50° field of view. Retinal fundus photograph
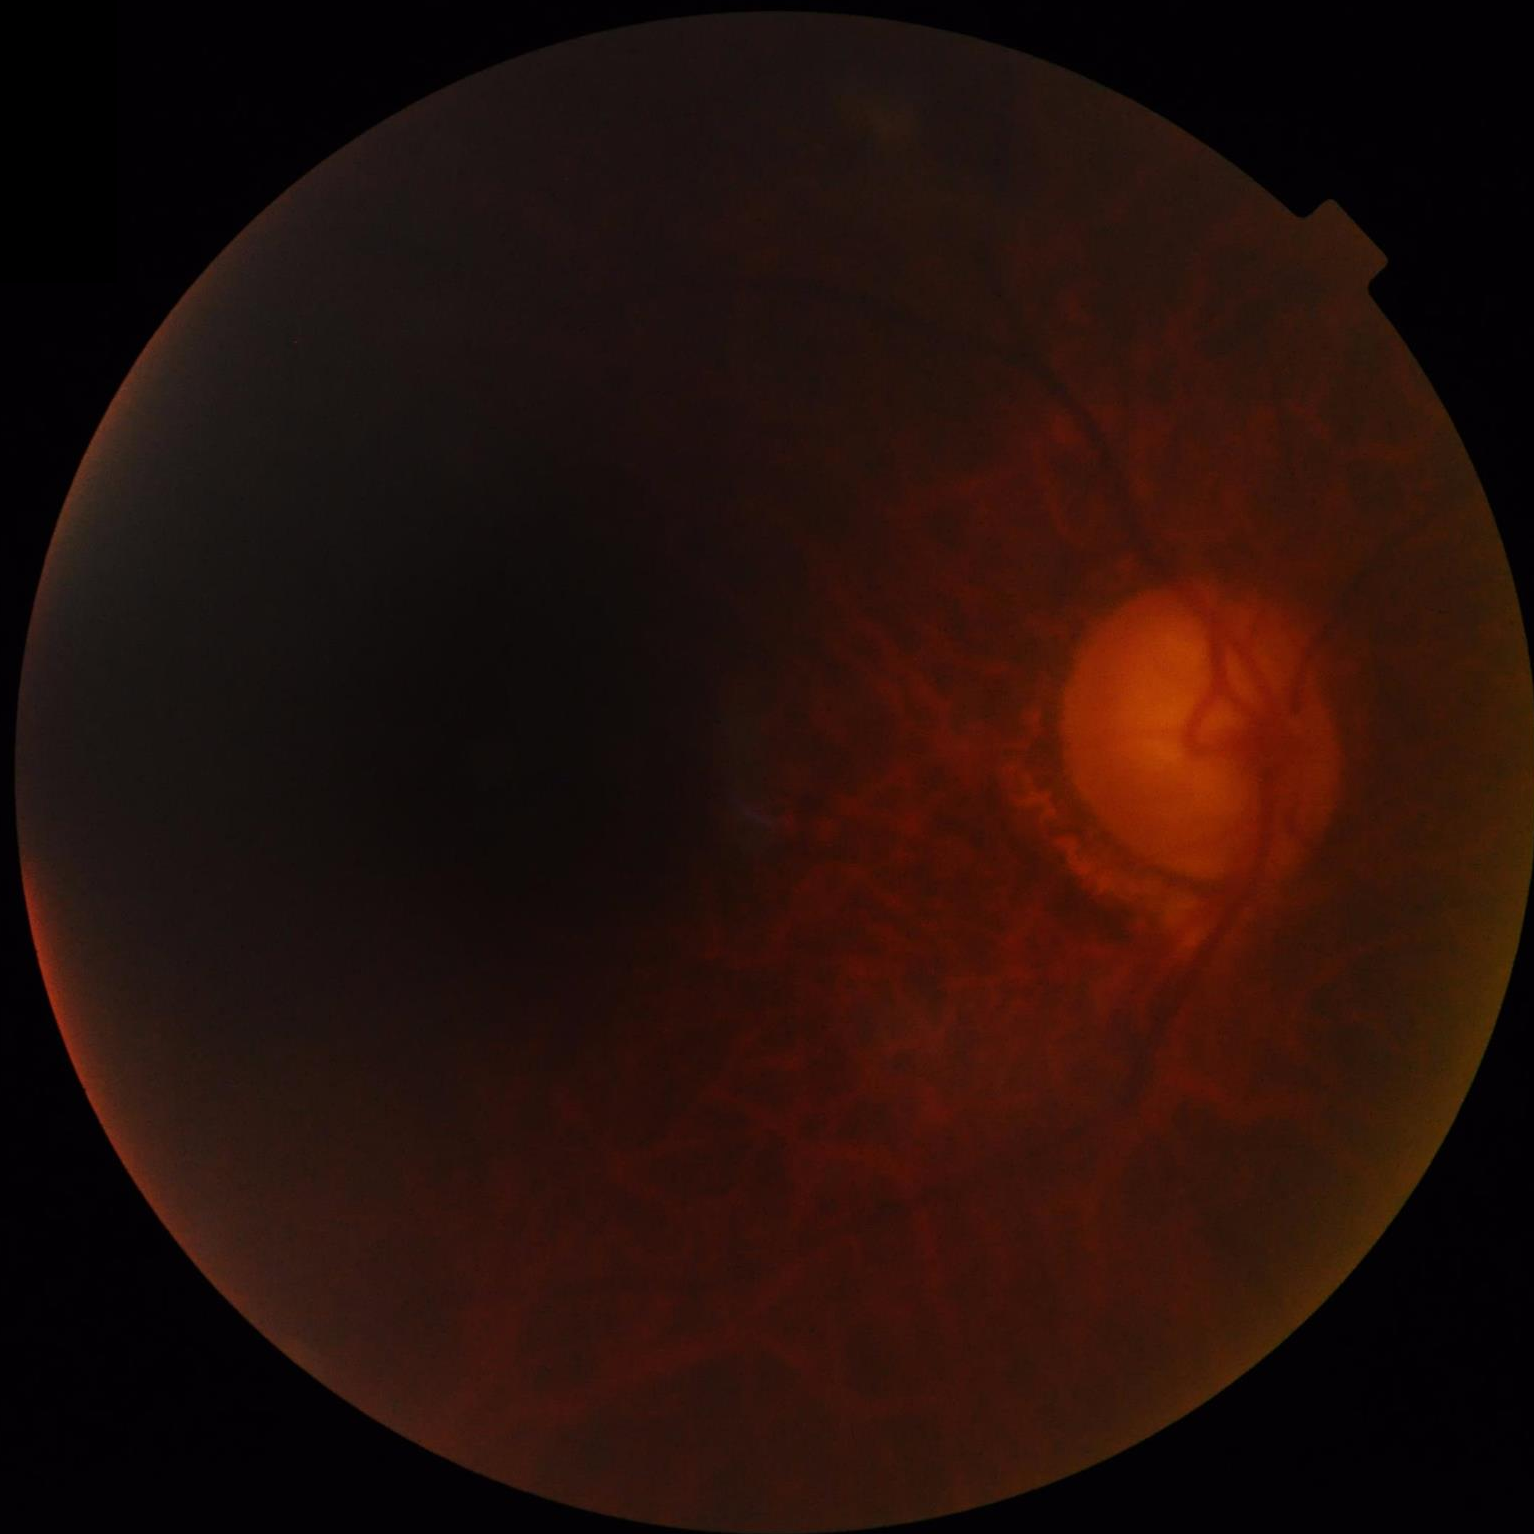

Overall quality = poor; Contrast = reduced; Illumination = suboptimal; Clarity = poor.